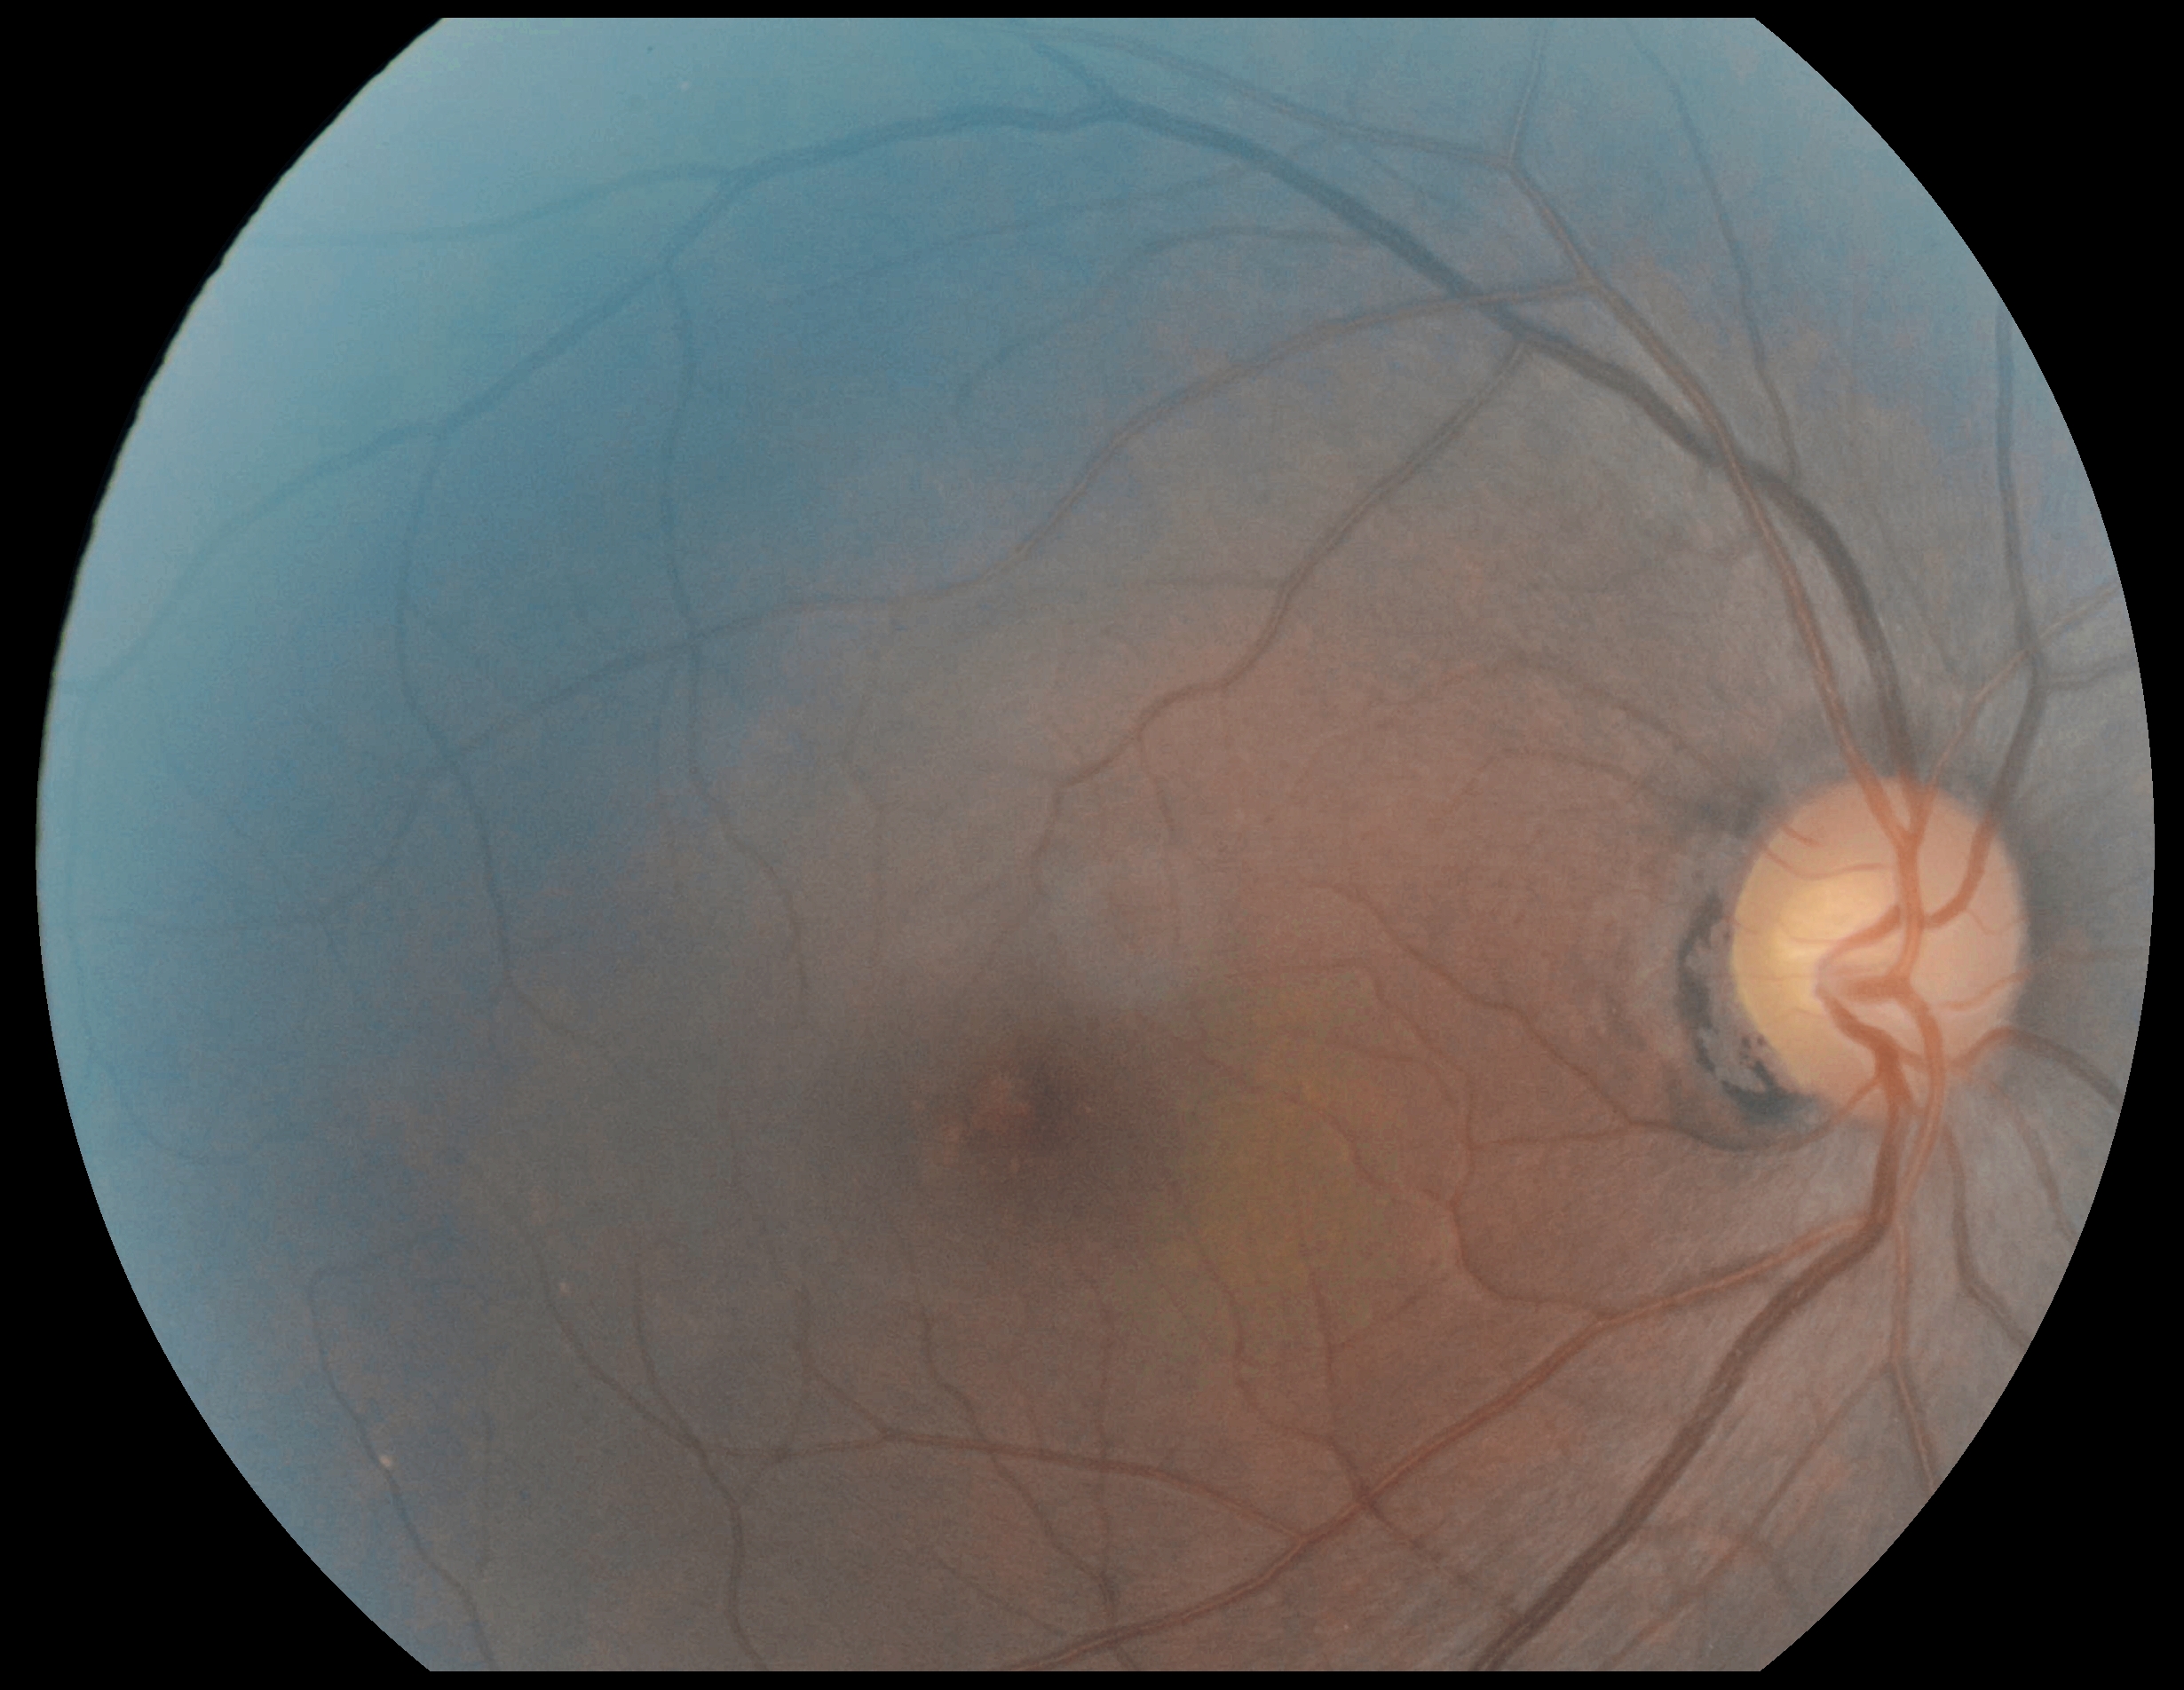

DR severity is no apparent retinopathy (grade 0).